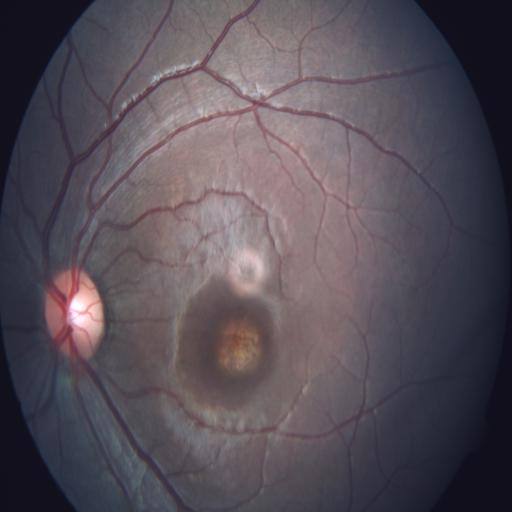

Findings: macular scar.